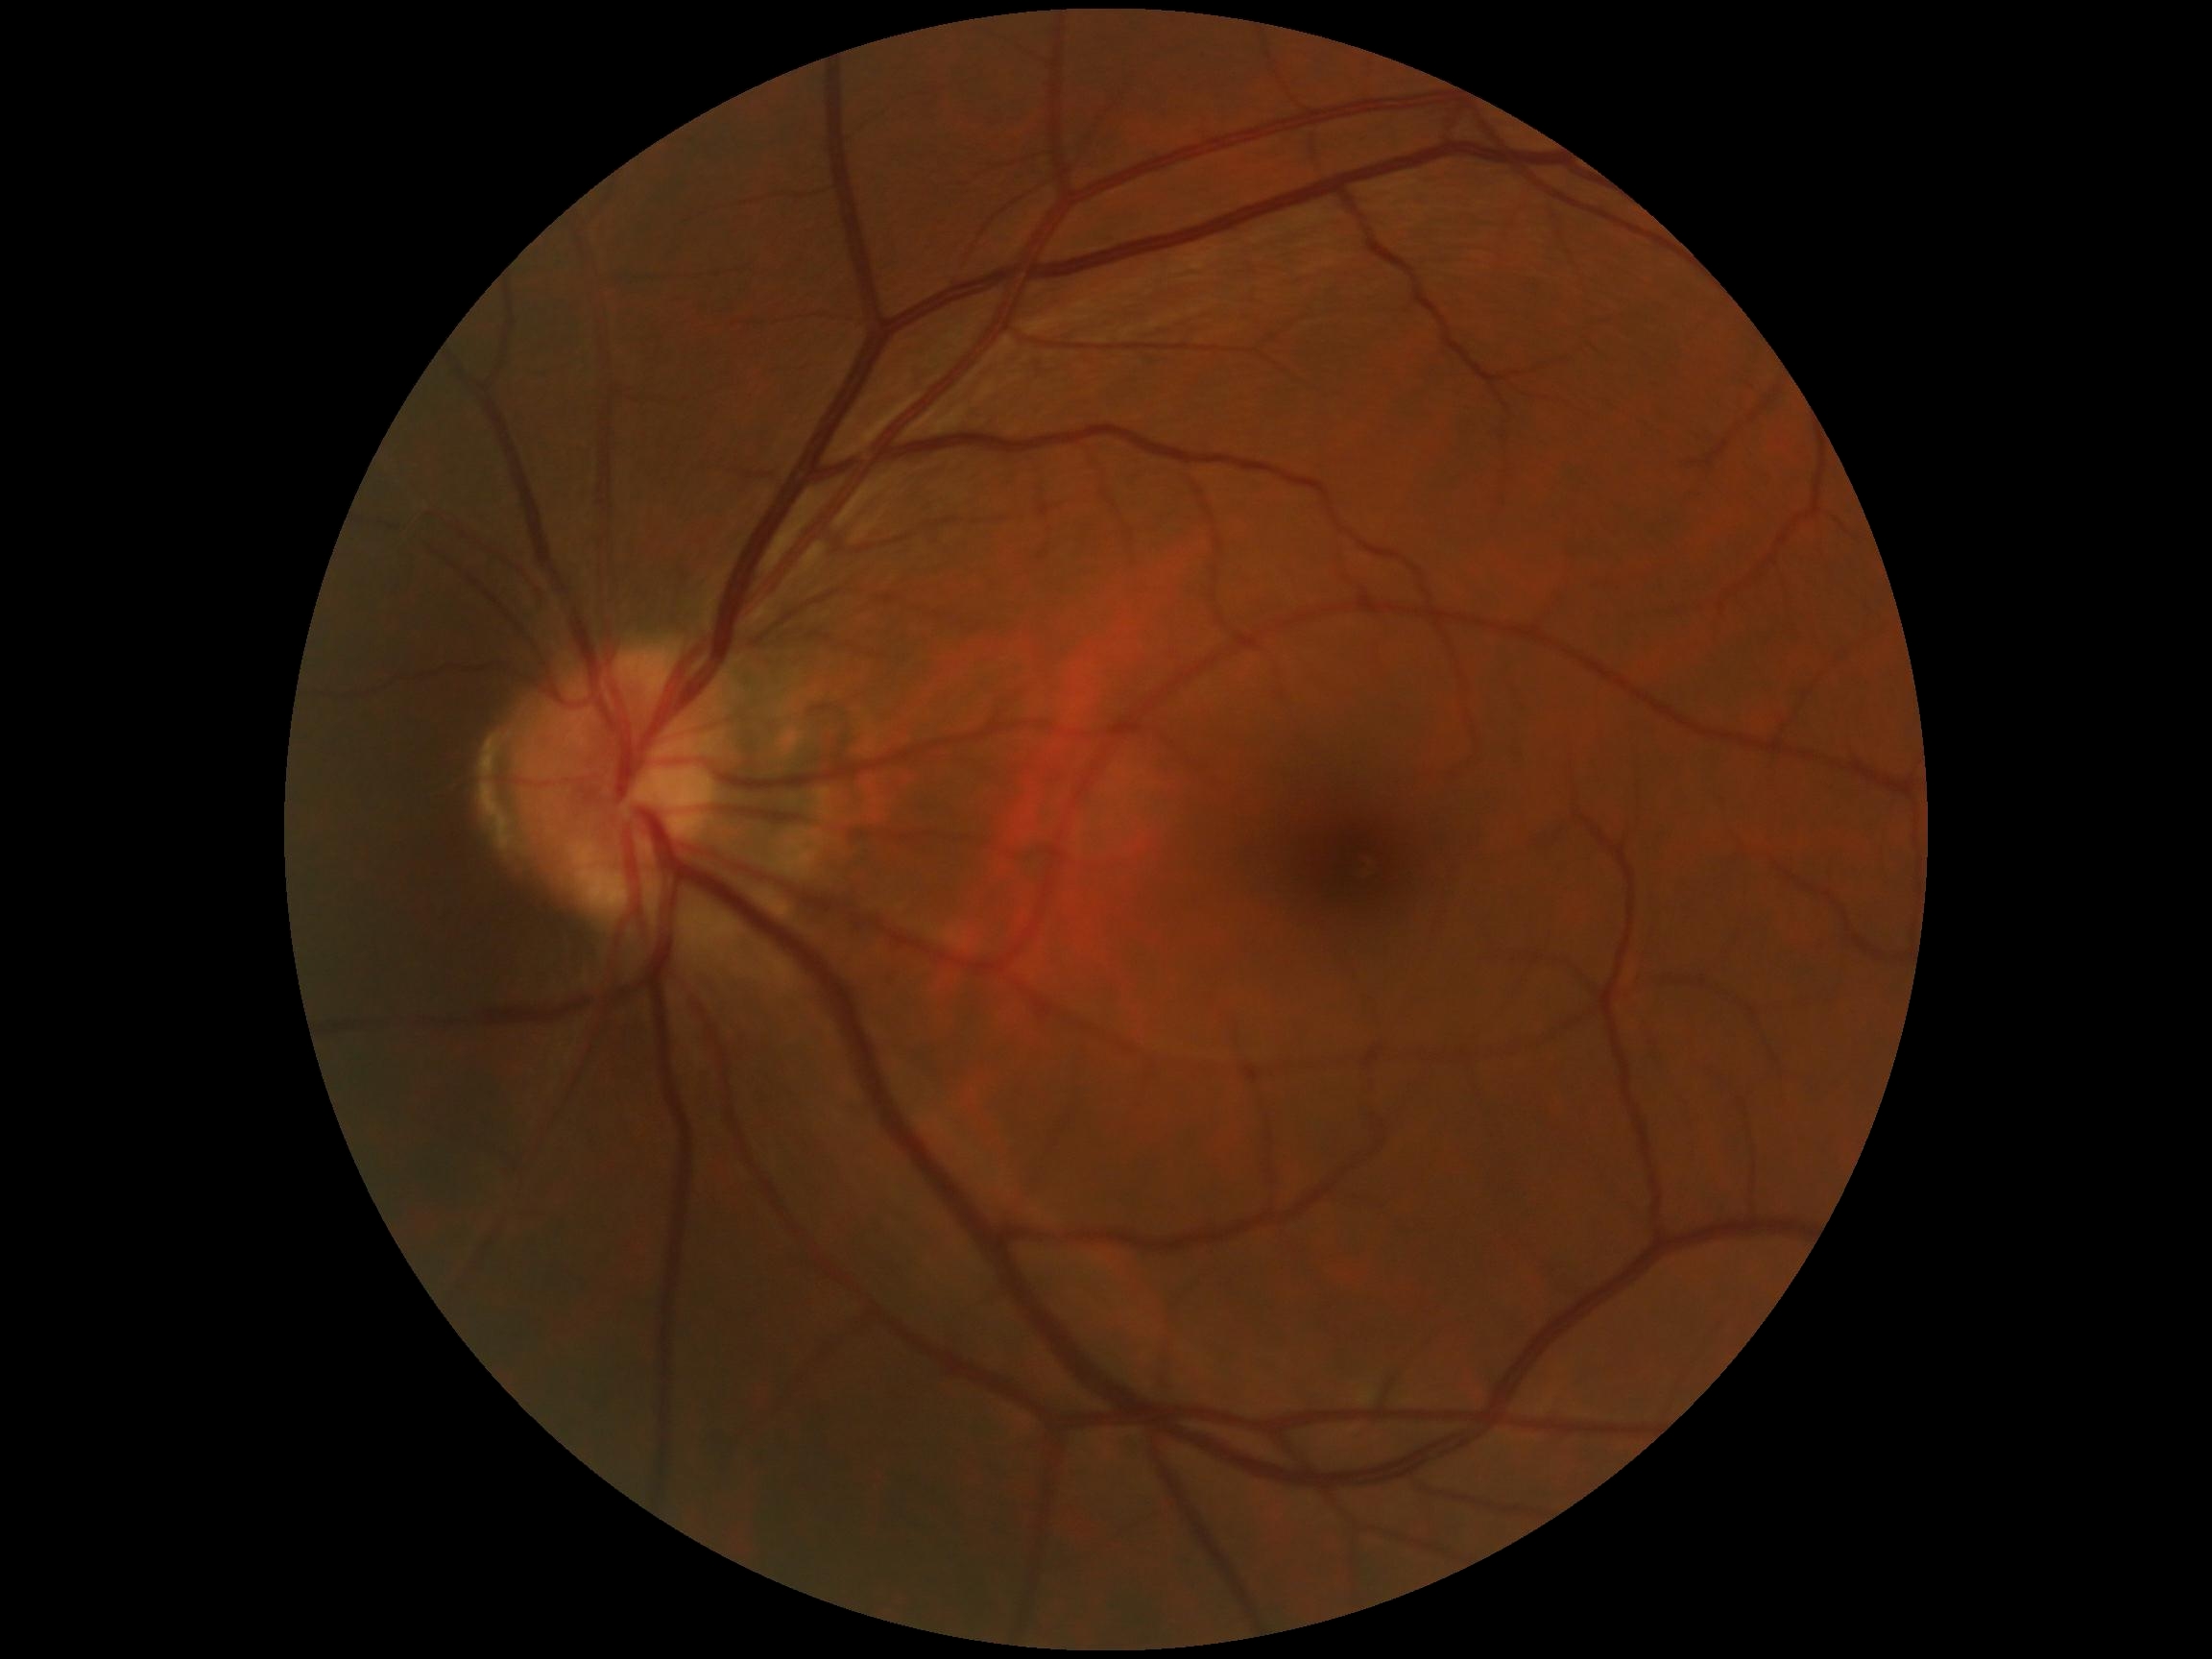
– diabetic retinopathy severity — no apparent diabetic retinopathy (grade 0)